Image size 2048x1536
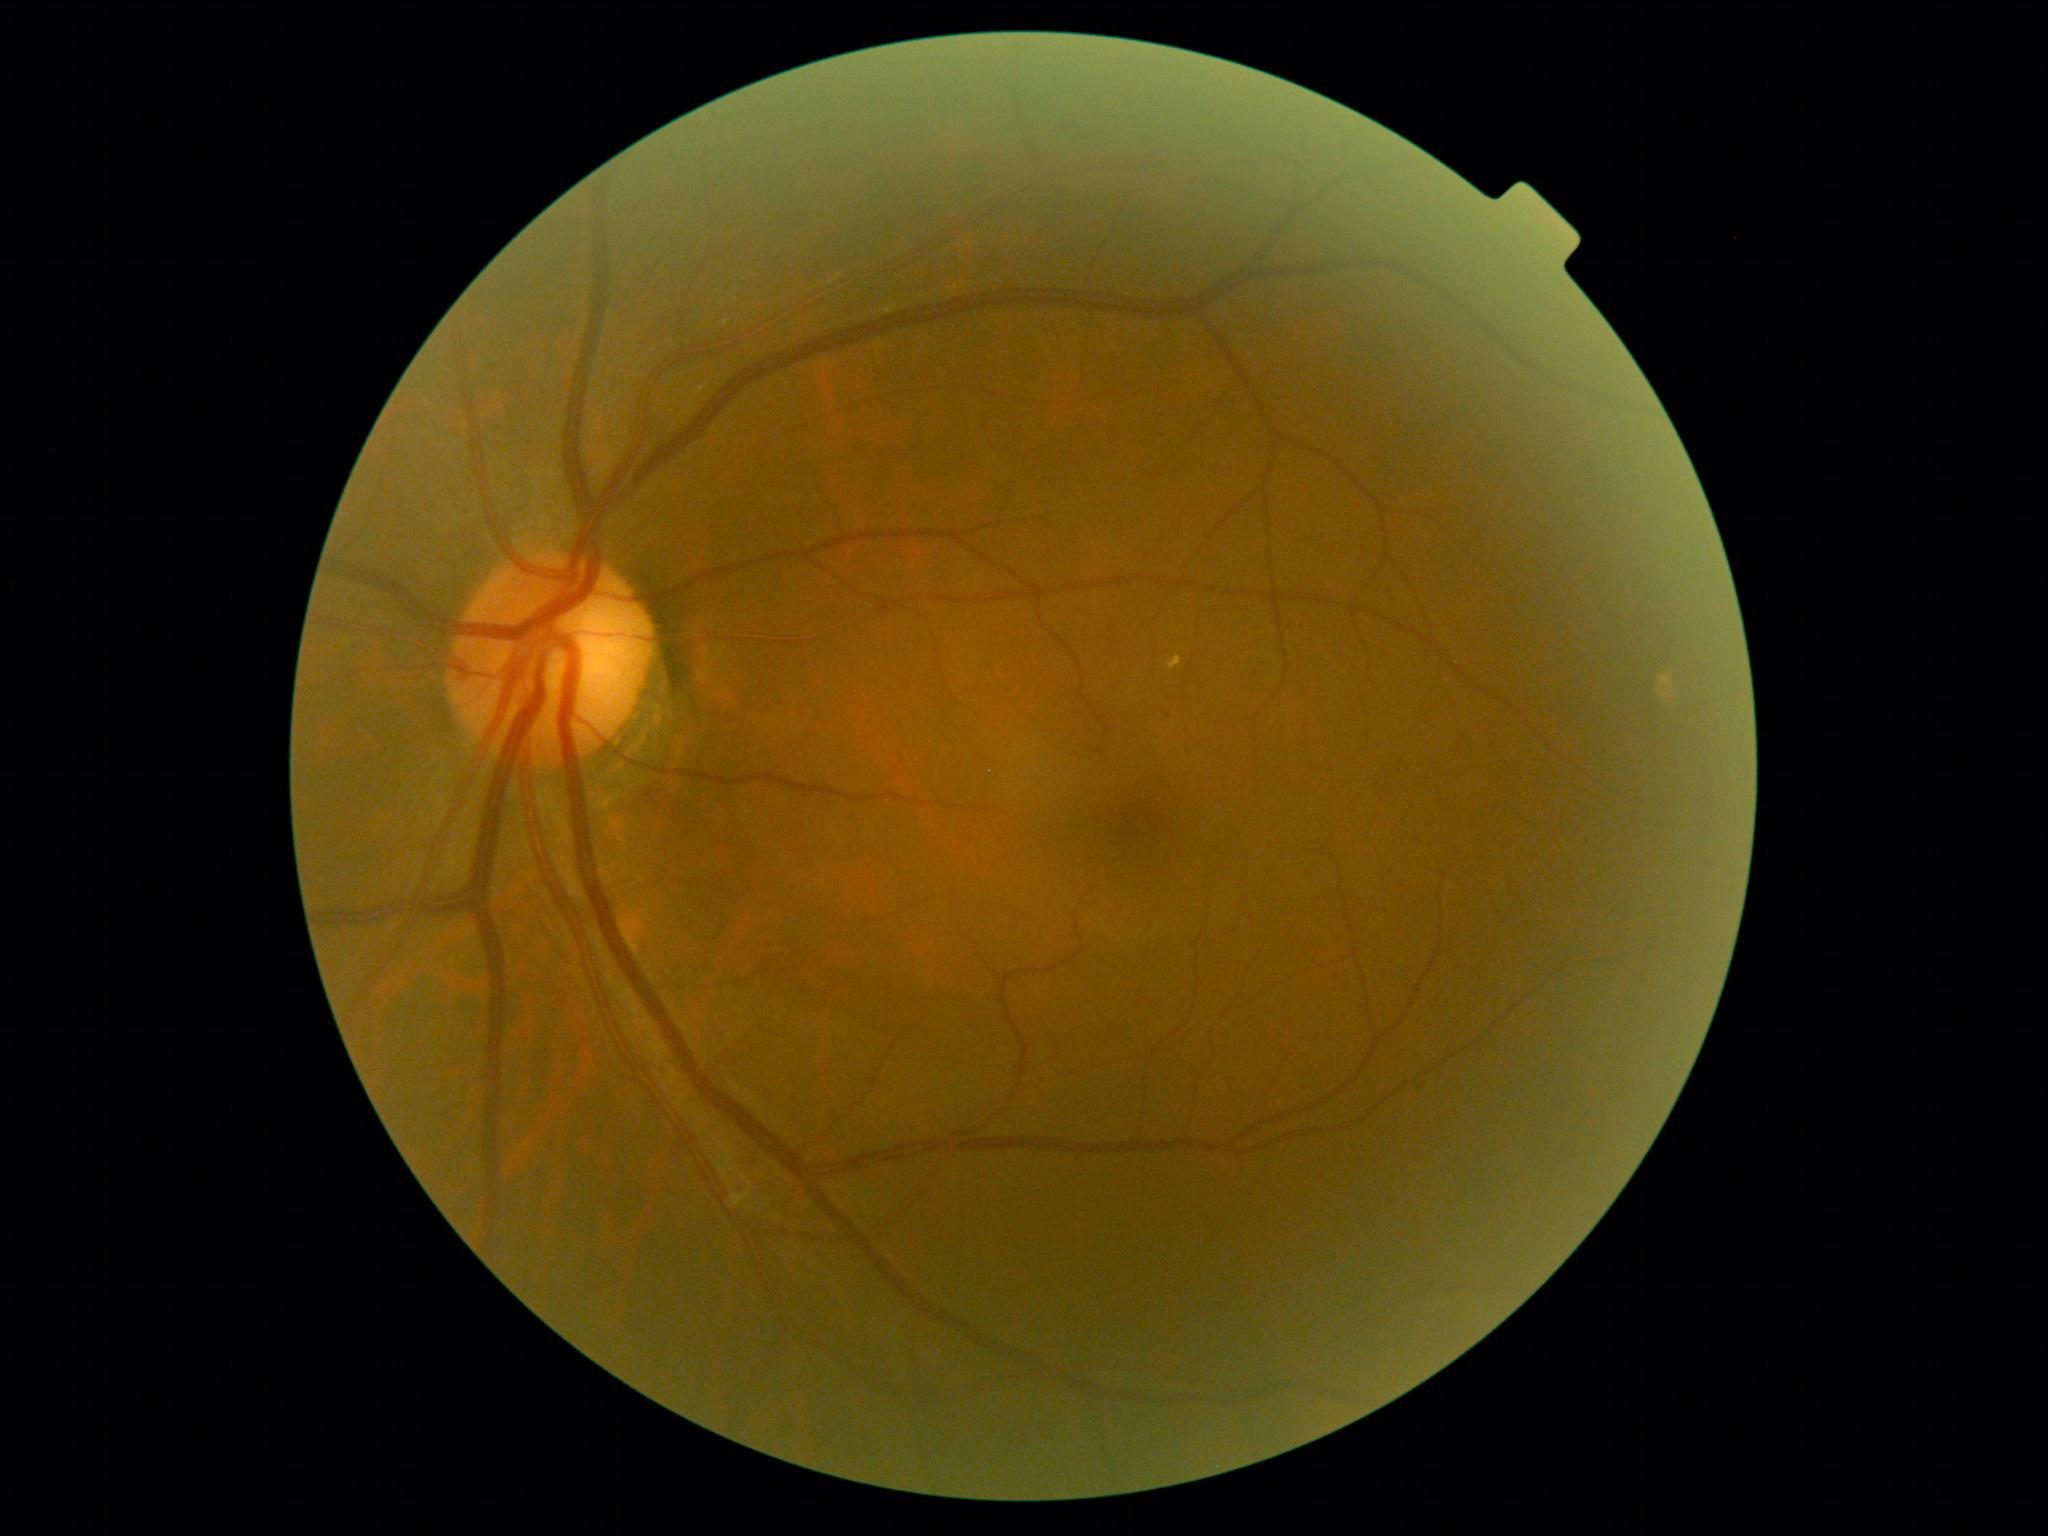

DR severity@2/4.